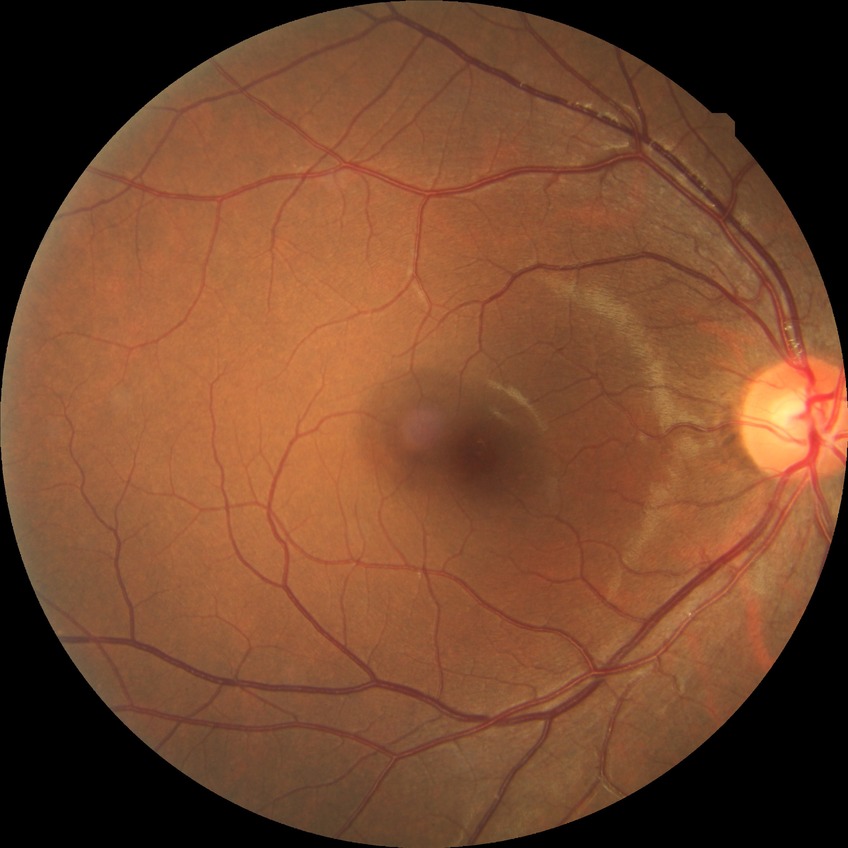
Diabetic retinopathy (DR) is NDR (no diabetic retinopathy).